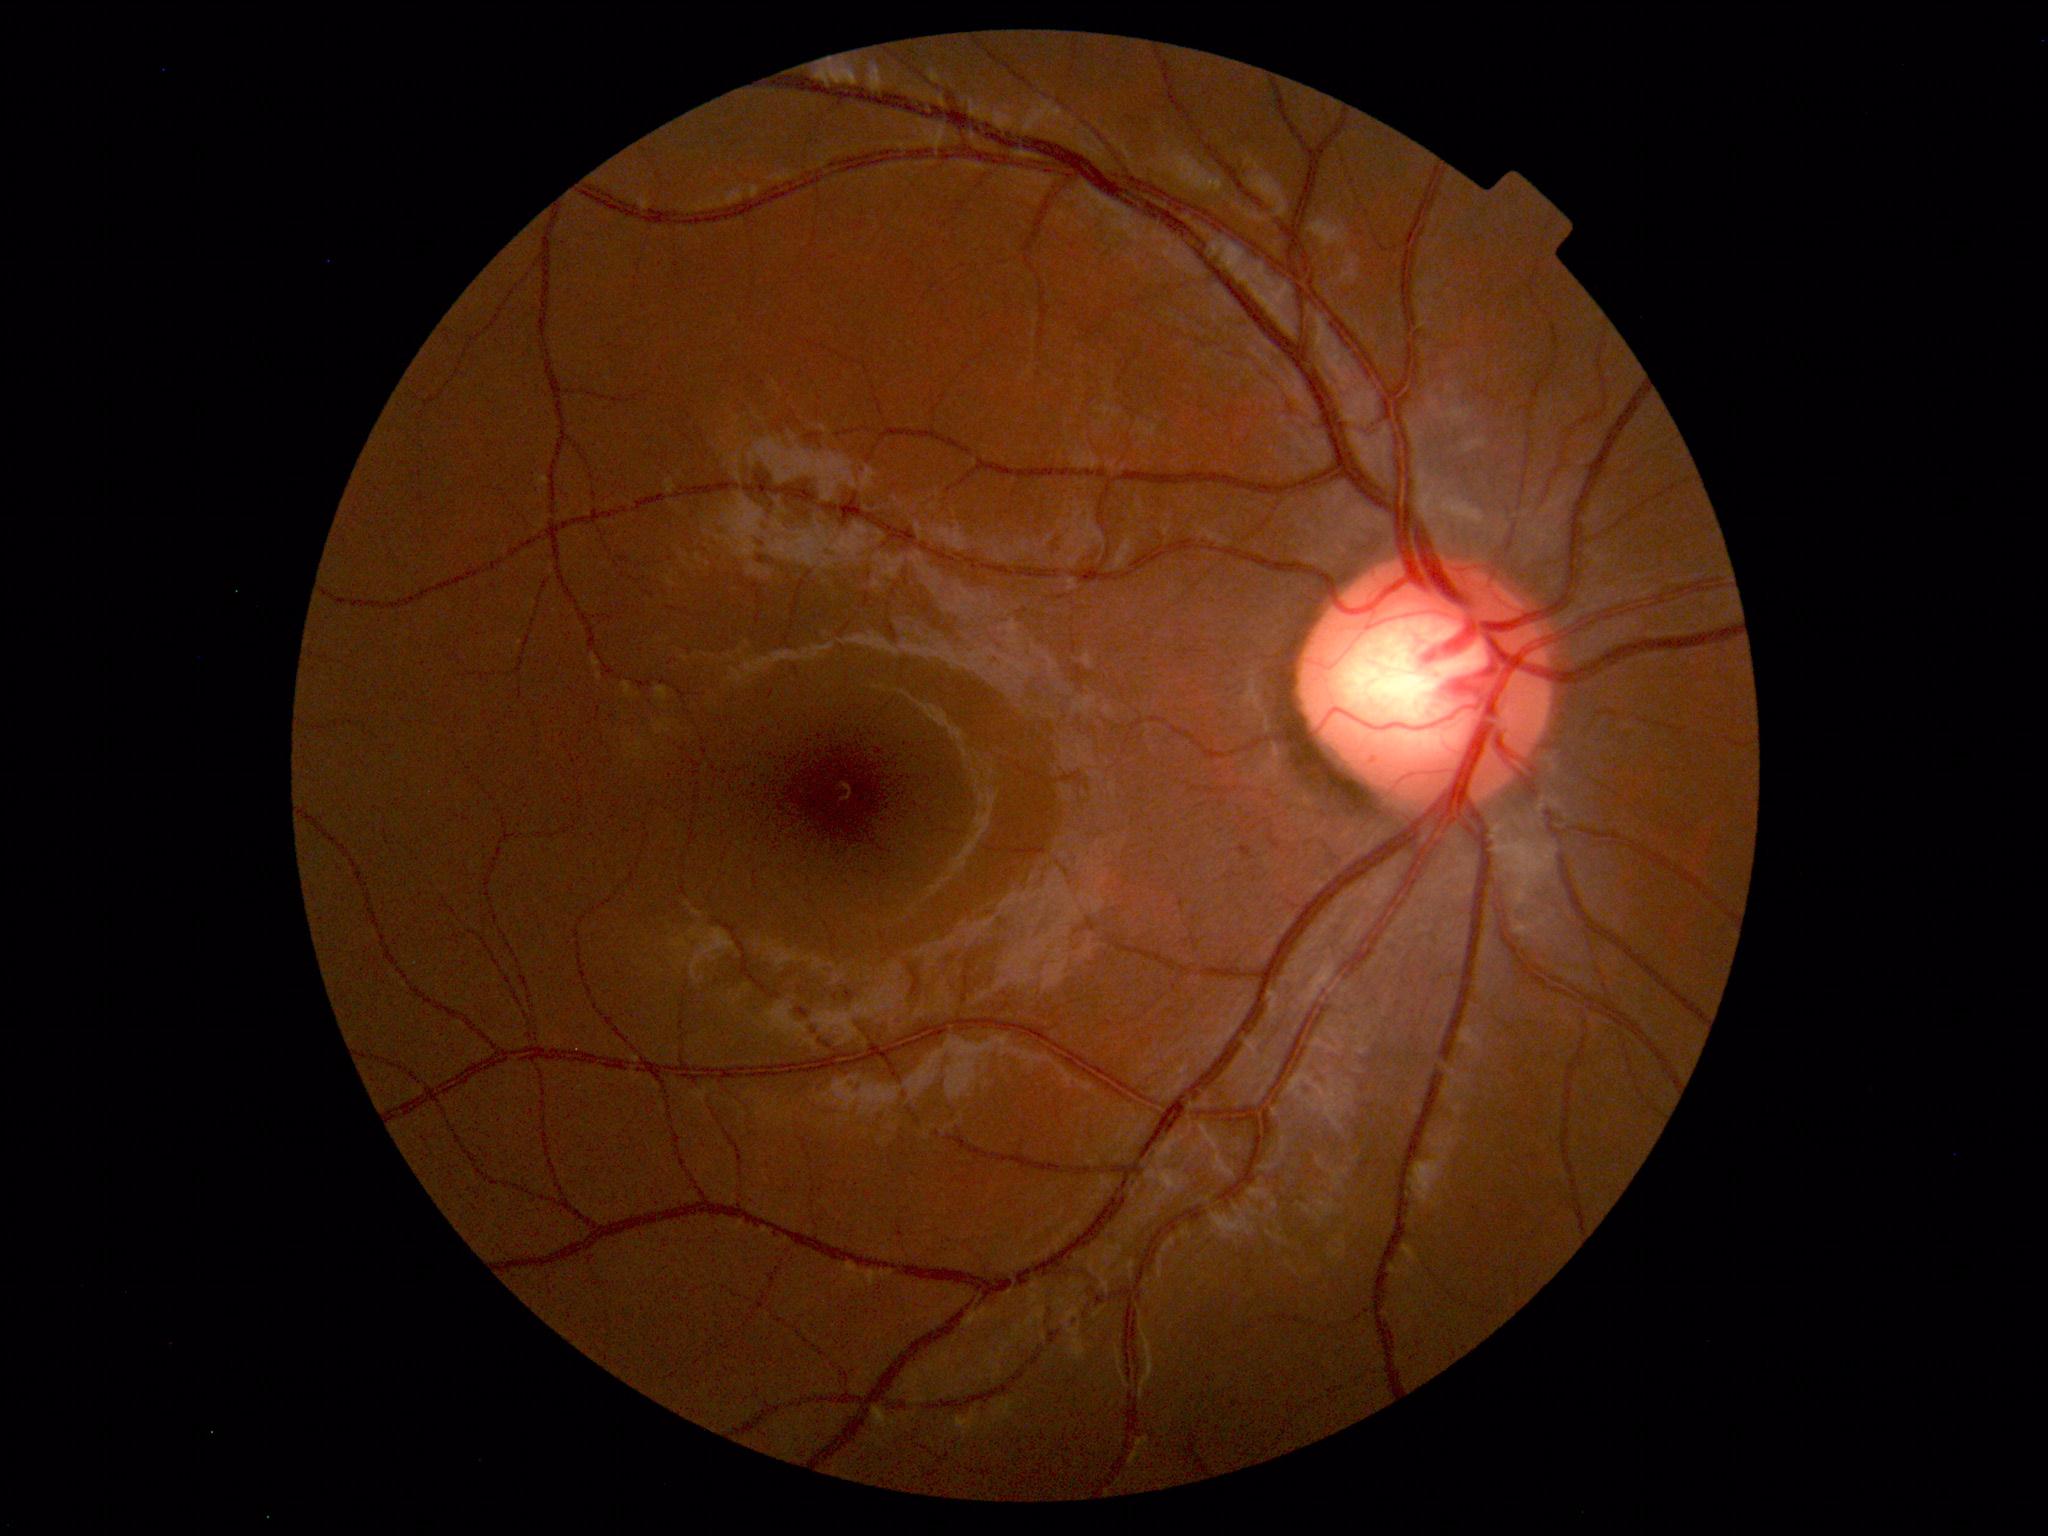
The fundus appears normal with no pathological findings.